45° FOV · 2352 by 1568 pixels · retinal fundus photograph.
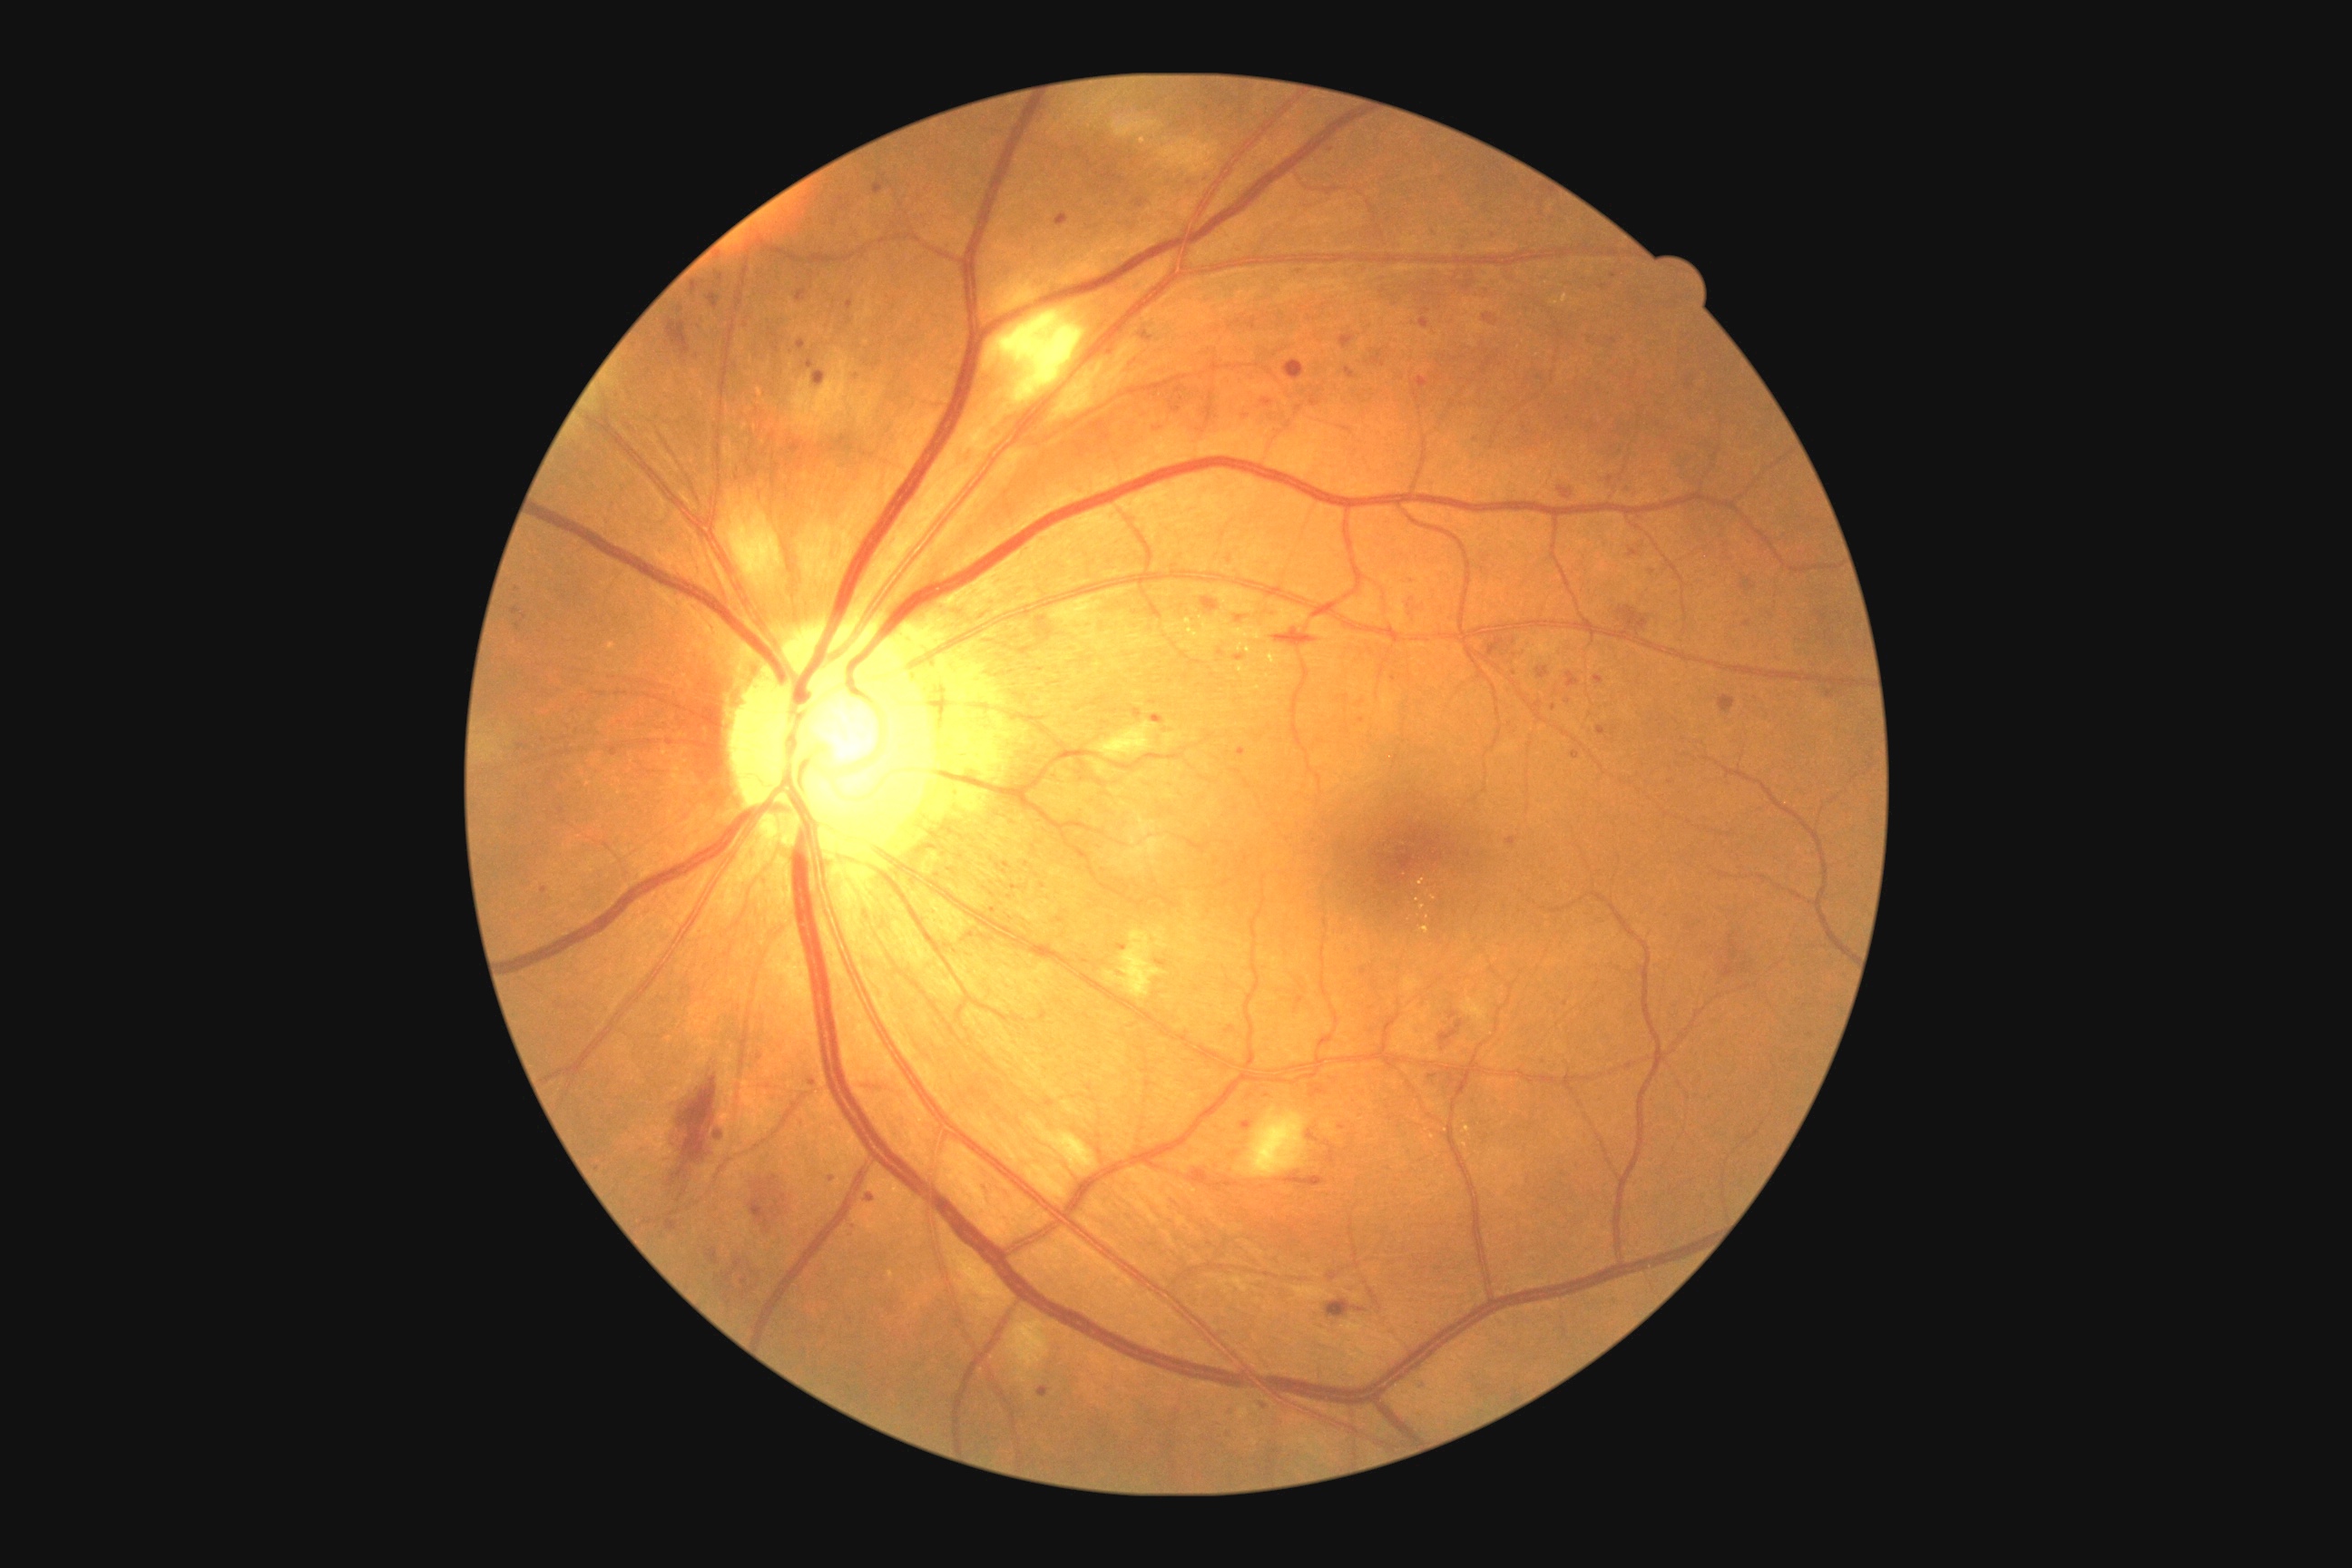
{"partial":true,"dr_grade":2,"lesions":{"ma":[[516,623,522,632],[1037,616,1054,642],[1152,716,1164,723],[1115,945,1126,950],[1133,709,1142,720],[1427,1075,1438,1079],[1740,580,1758,591],[1827,691,1836,700],[1420,318,1429,331],[1340,335,1355,349],[667,1220,678,1231],[1416,377,1429,389],[807,360,814,369]],"ma_small":[[1017,888],[1393,678],[1149,1084],[1267,1096],[598,1169],[1514,672],[813,1083]]}}